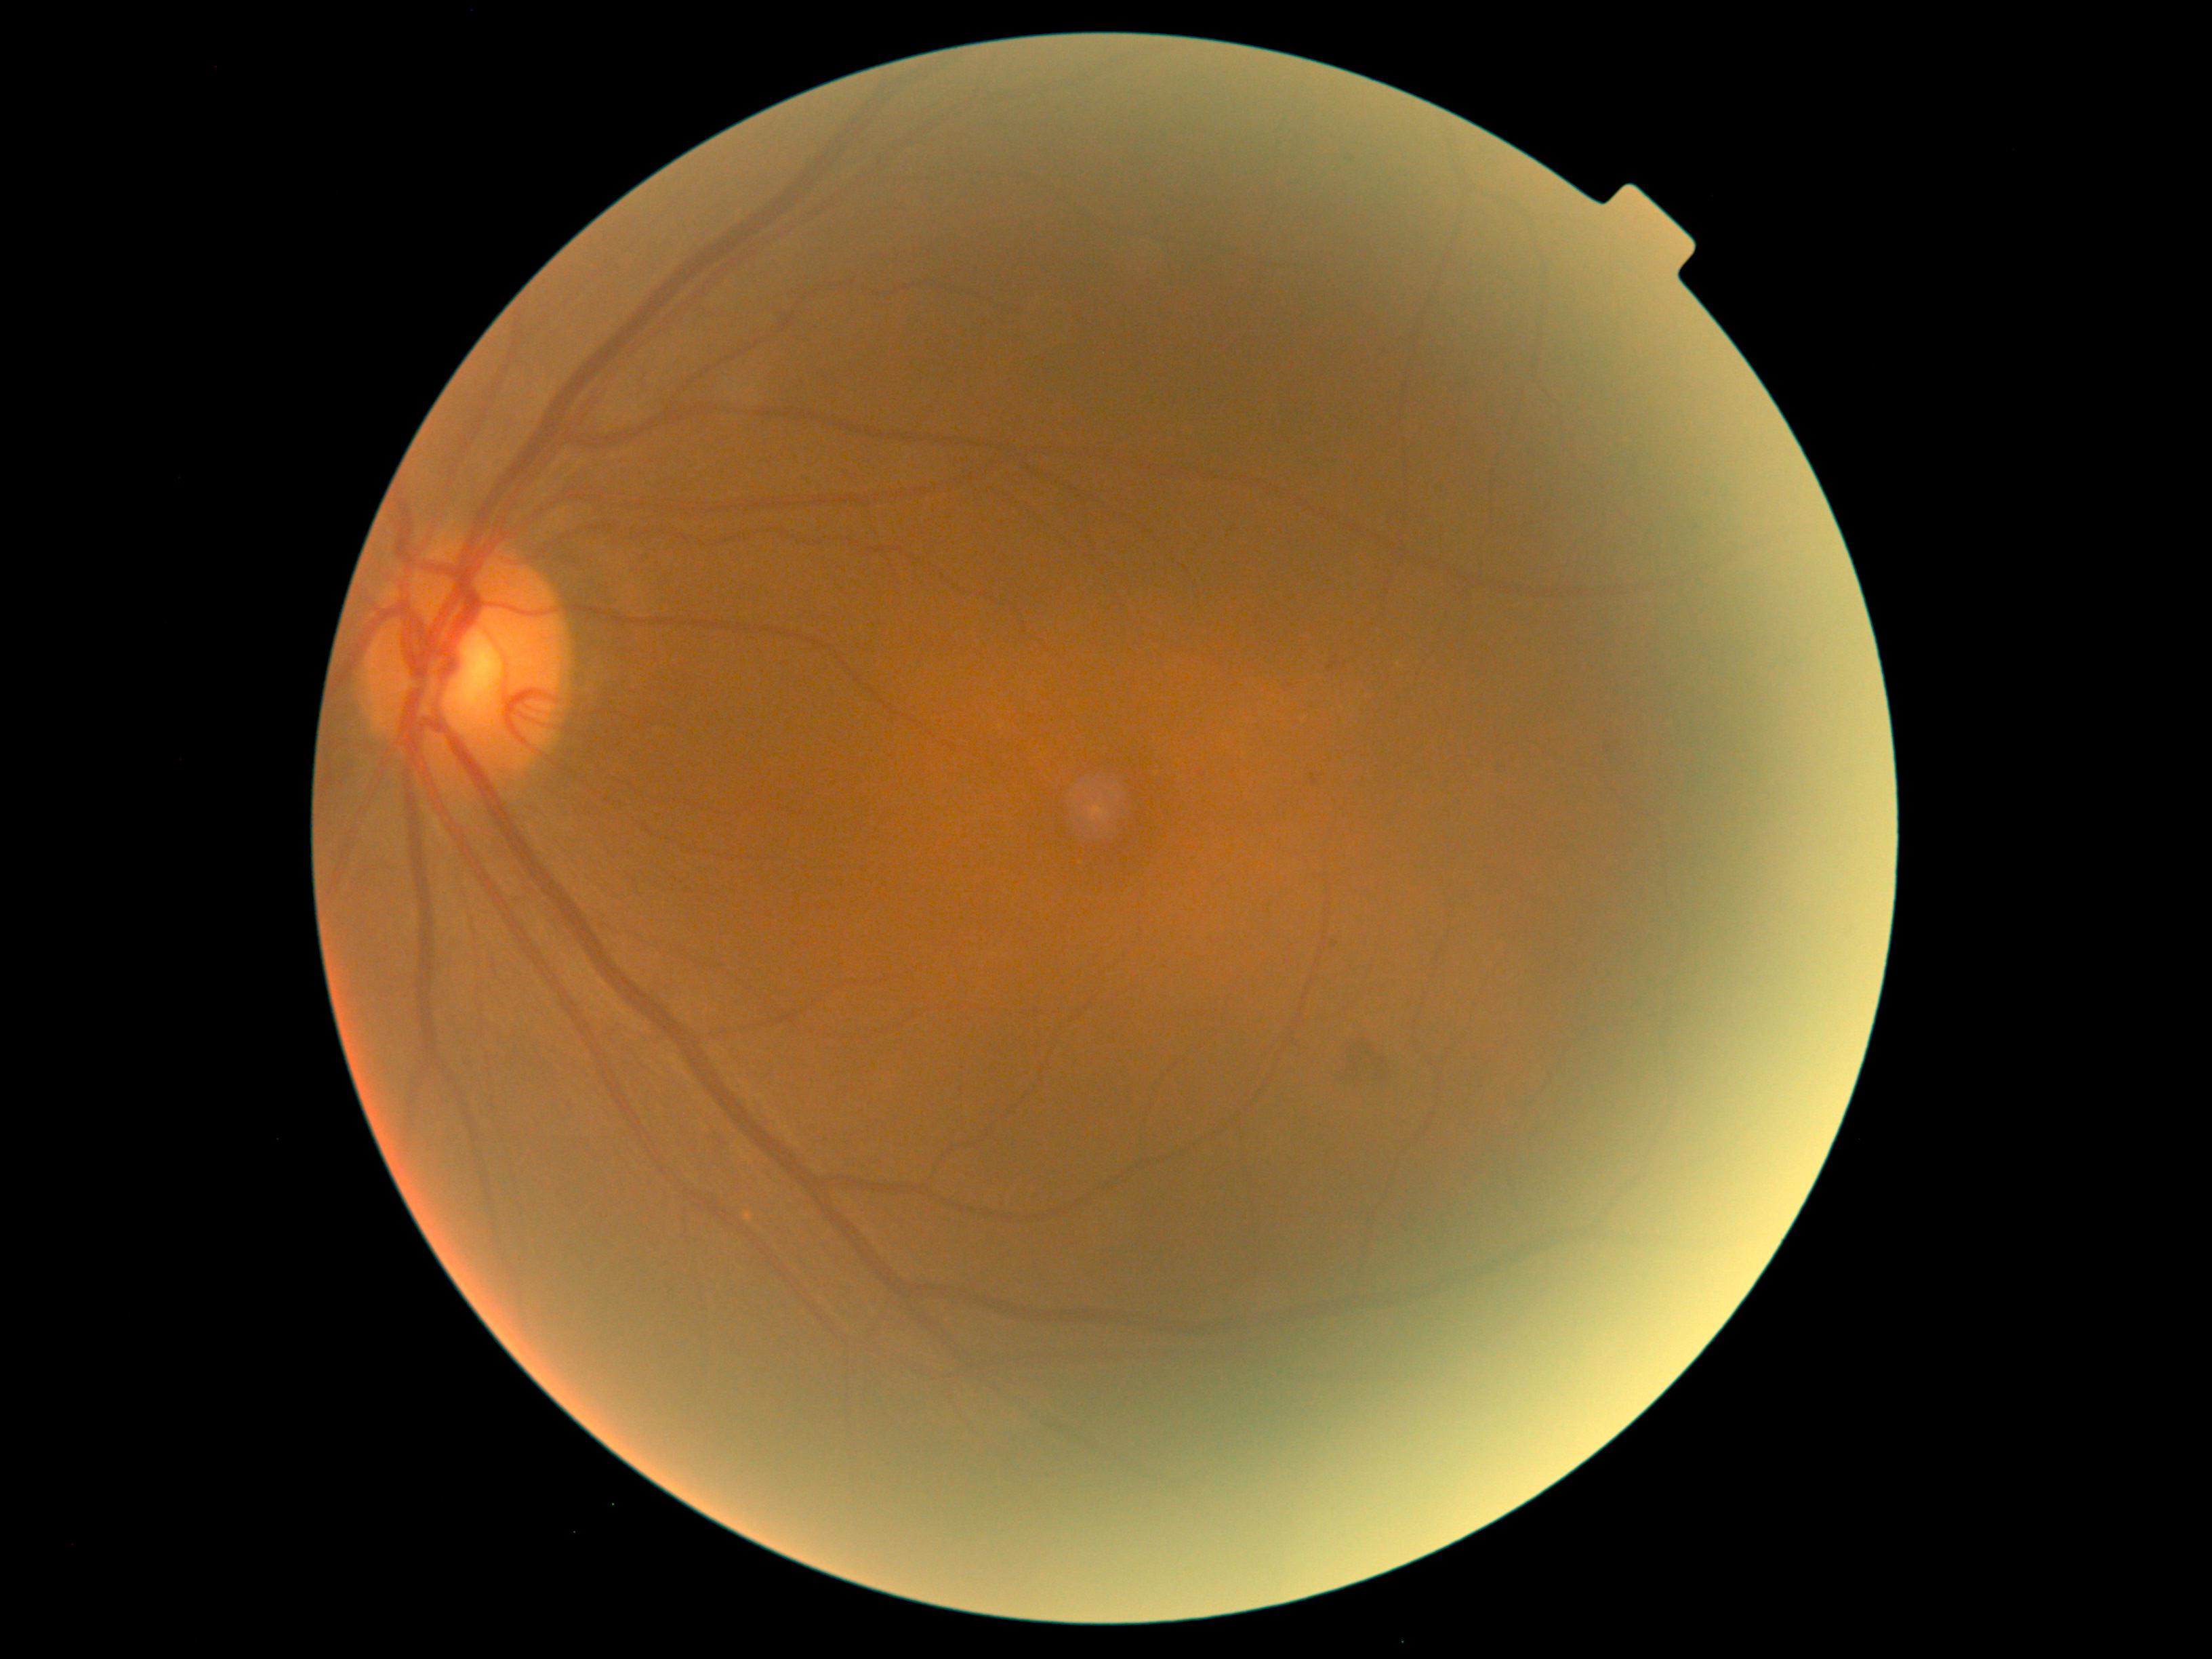 DR grade: 2.